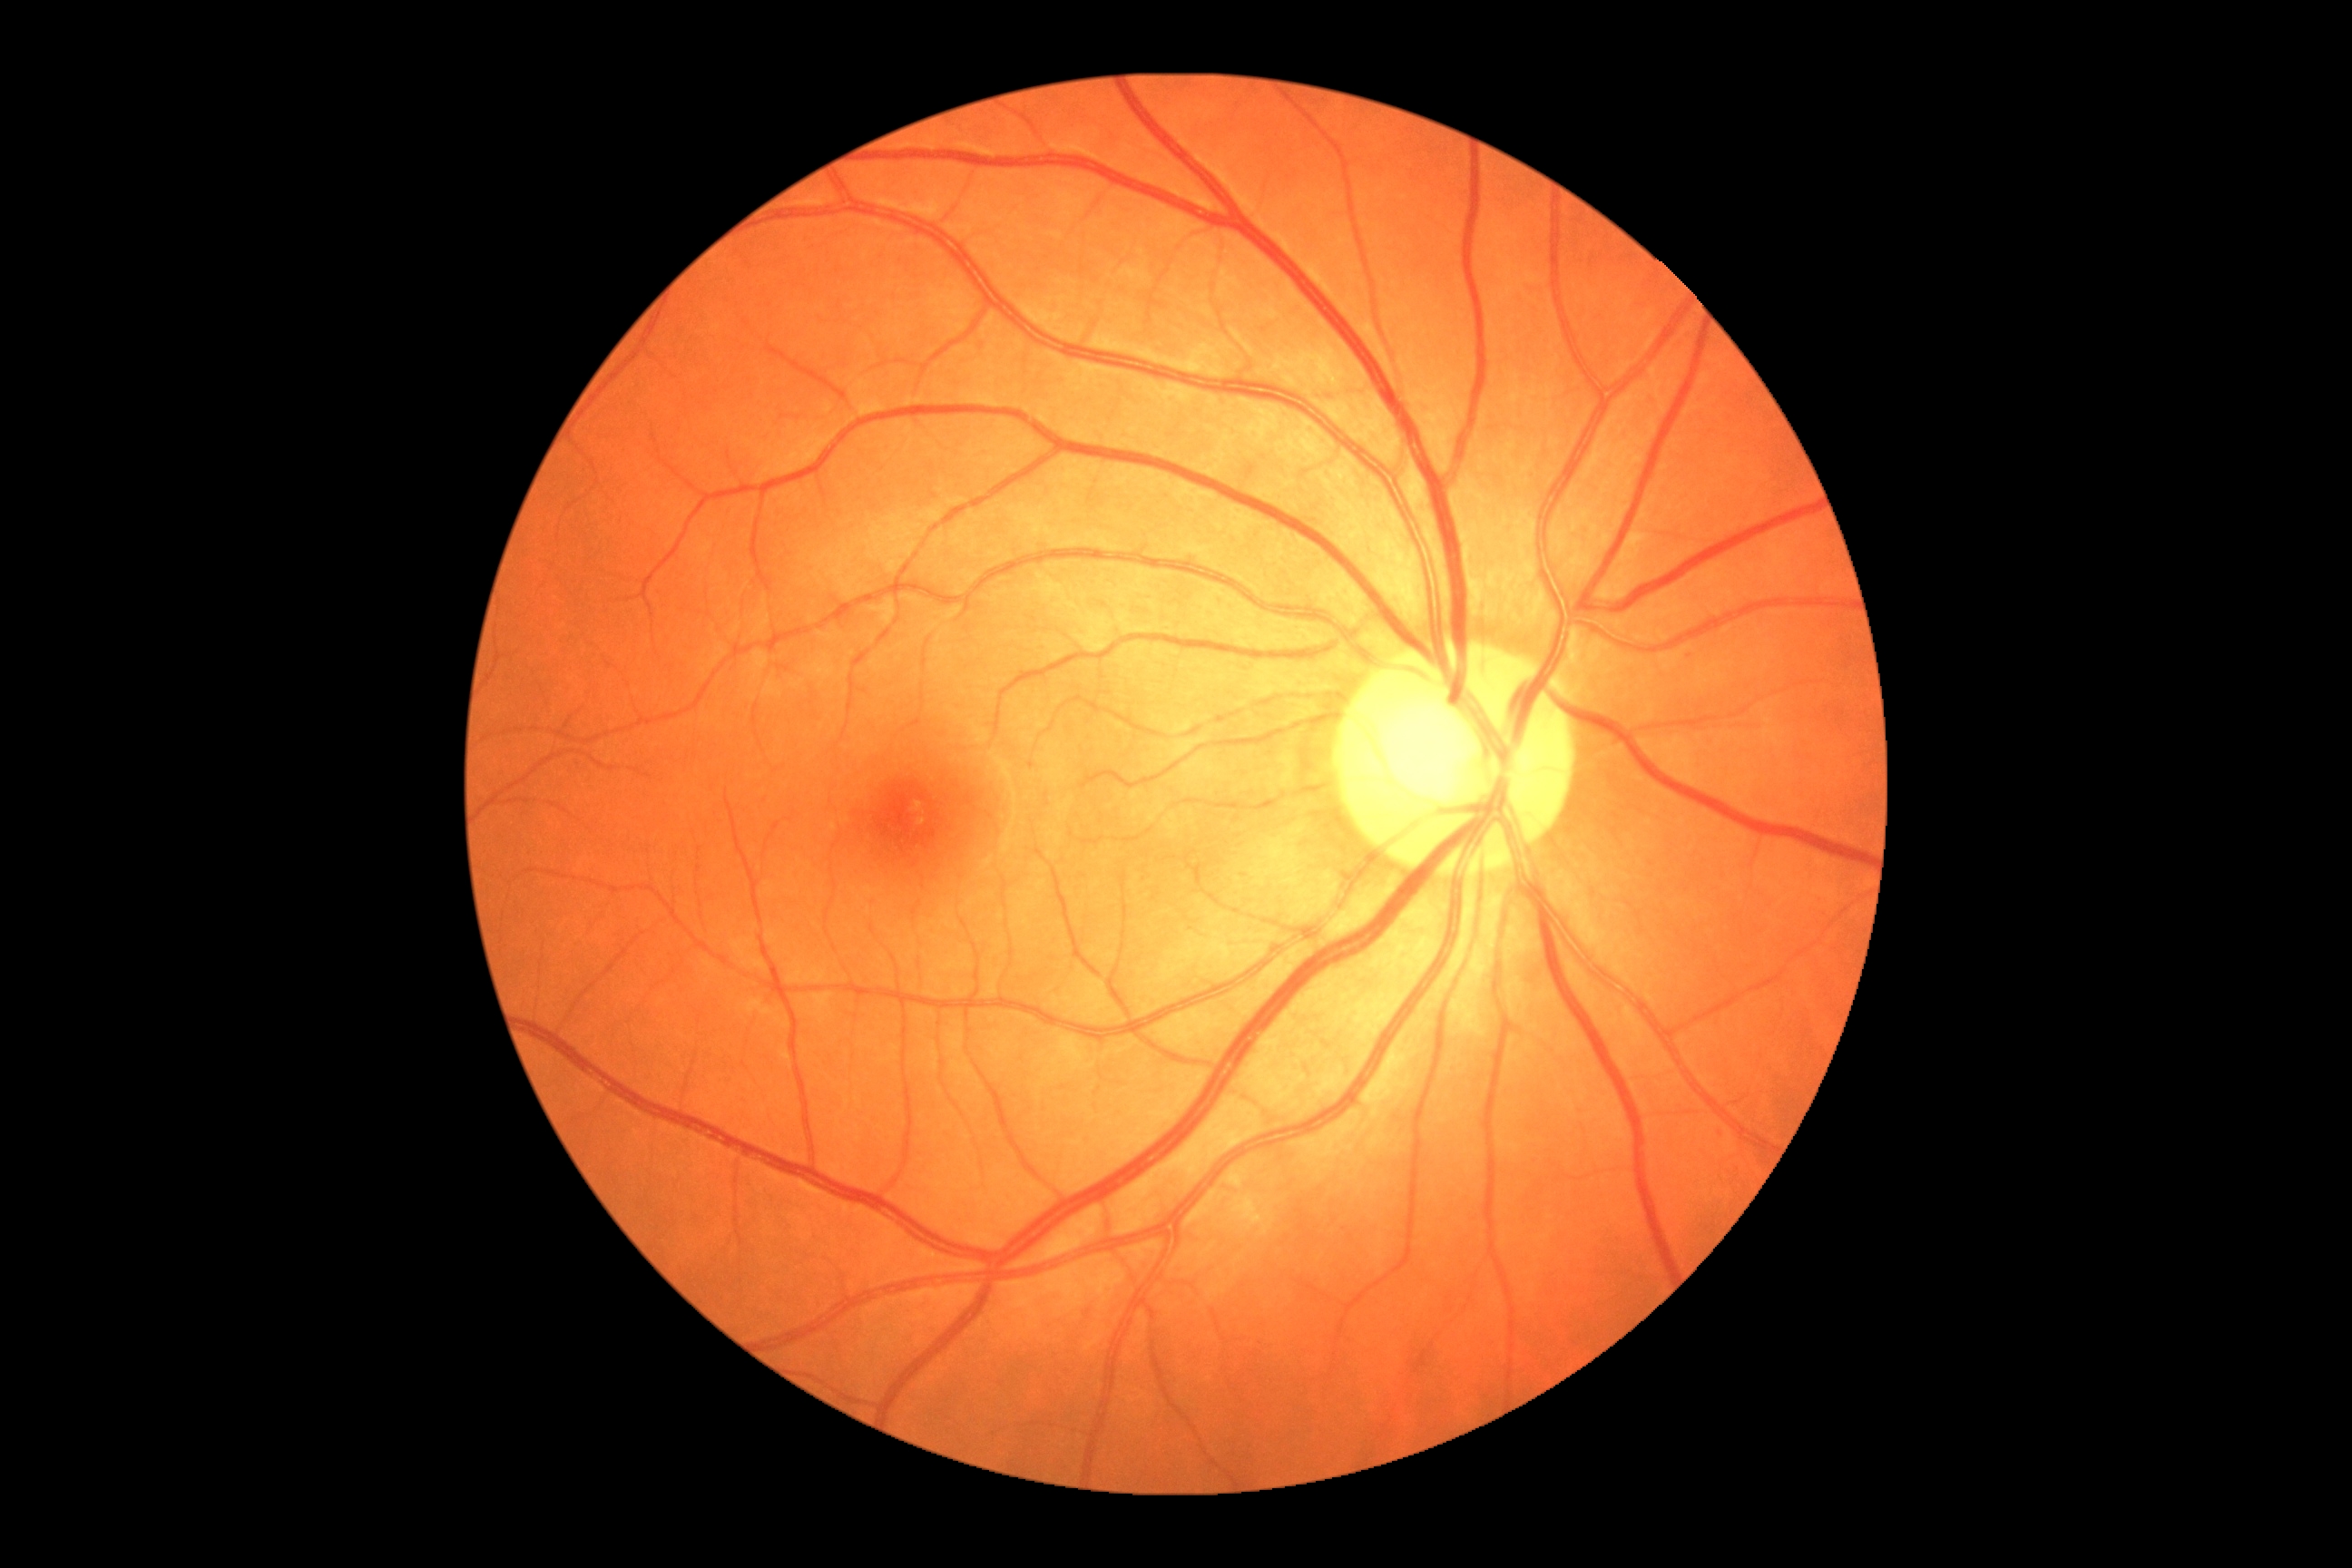

Diabetic retinopathy: grade 0 (no apparent retinopathy).